Retinal fundus photograph; 240x240px:
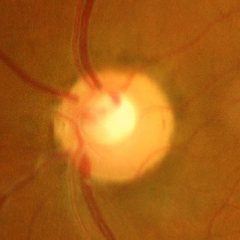

Glaucomatous changes are present. Glaucoma status: severe glaucomatous damage.